Camera: Phoenix ICON (100° FOV); pediatric retinal photograph (wide-field) — 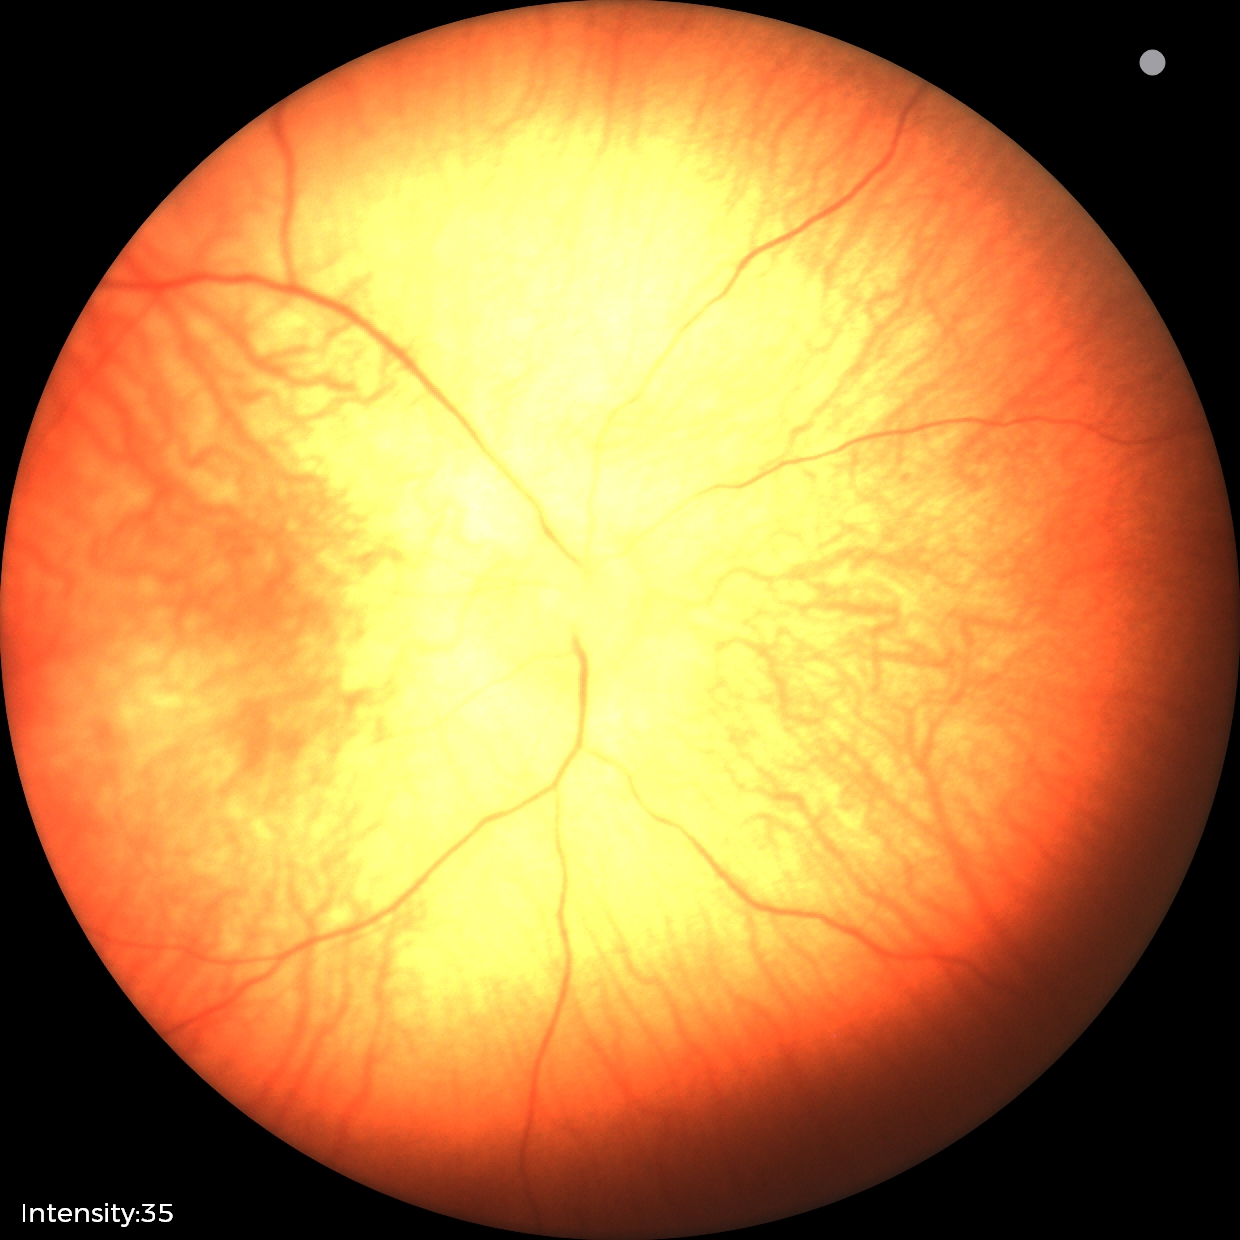 No retinal pathology identified on screening.